2352 by 1568 pixels, FOV: 45 degrees:
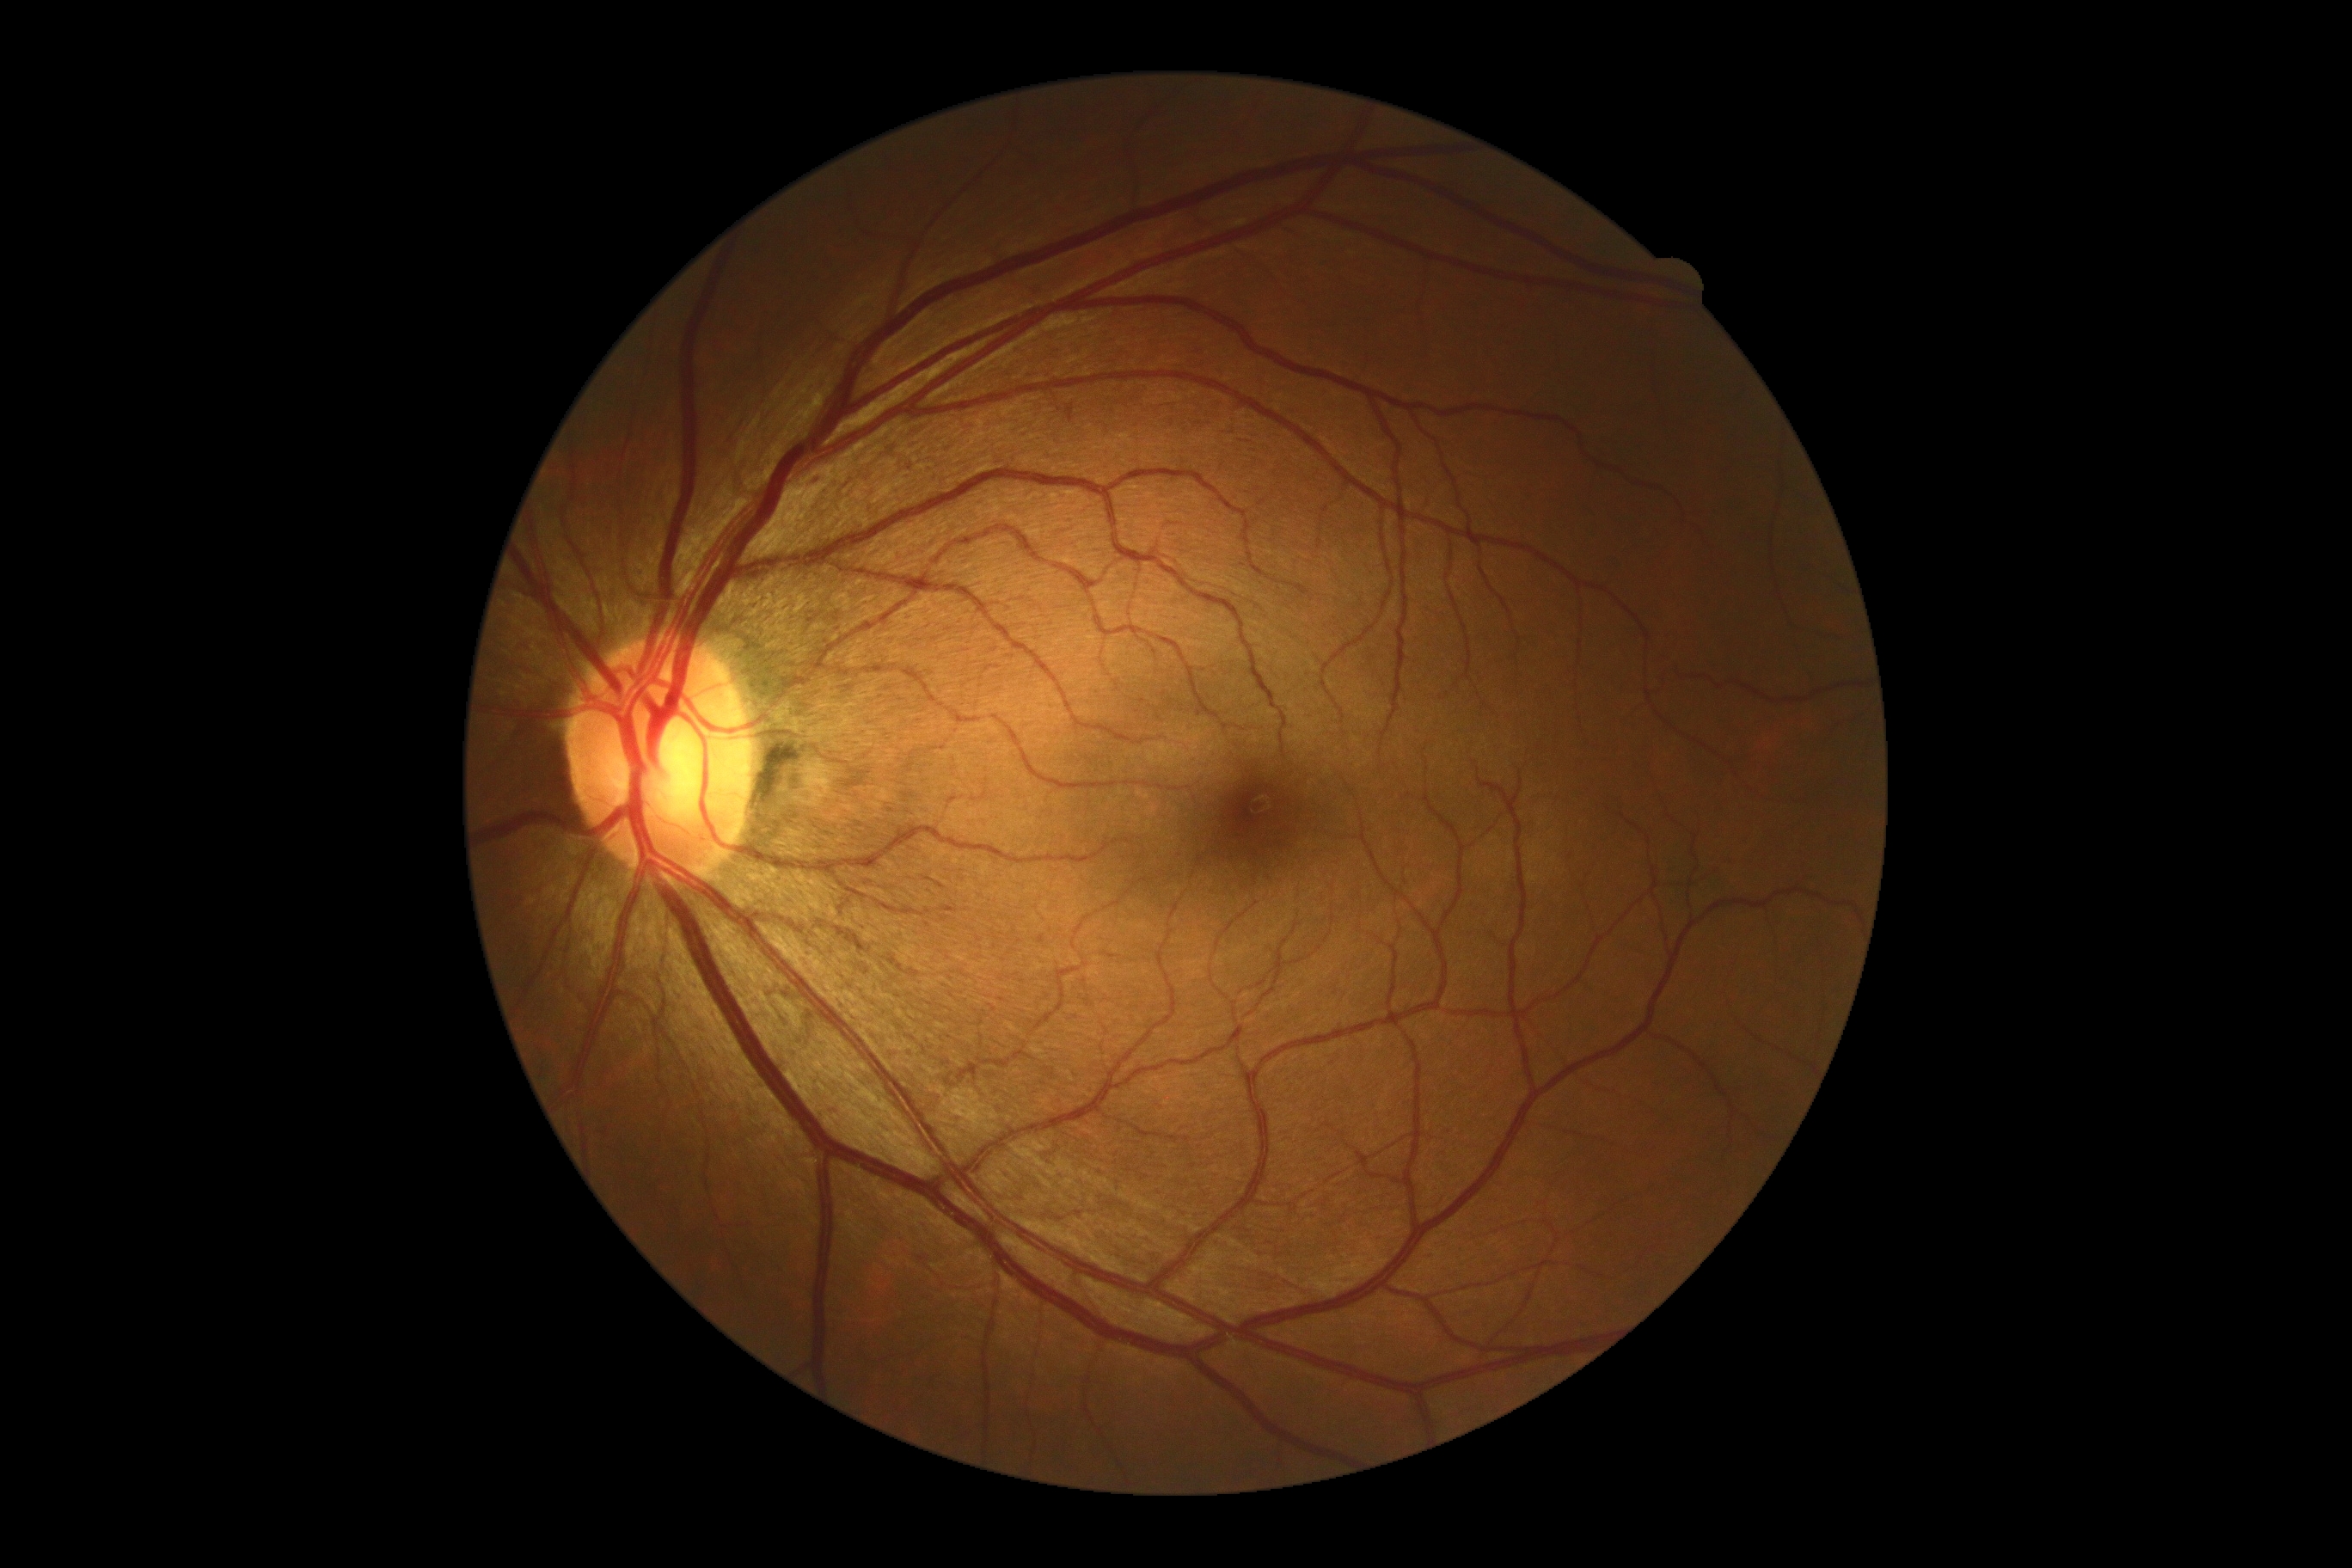

Diabetic retinopathy grade: no apparent diabetic retinopathy (0).